Acquired with a NIDEK AFC-230 — 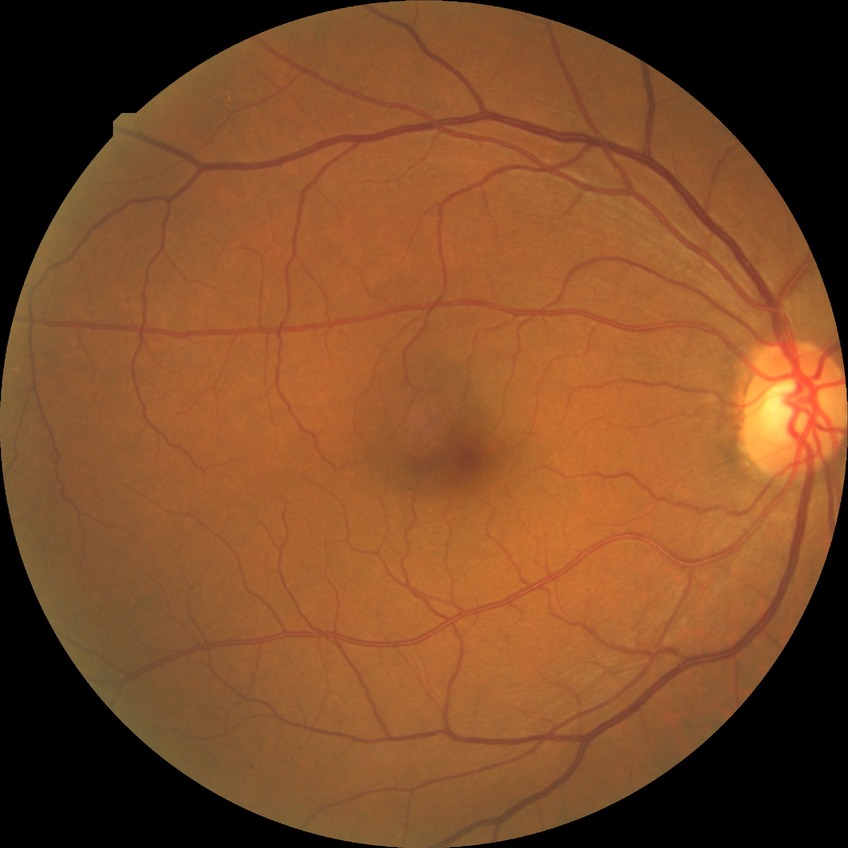 {
  "davis_grade": "no diabetic retinopathy (NDR)"
}